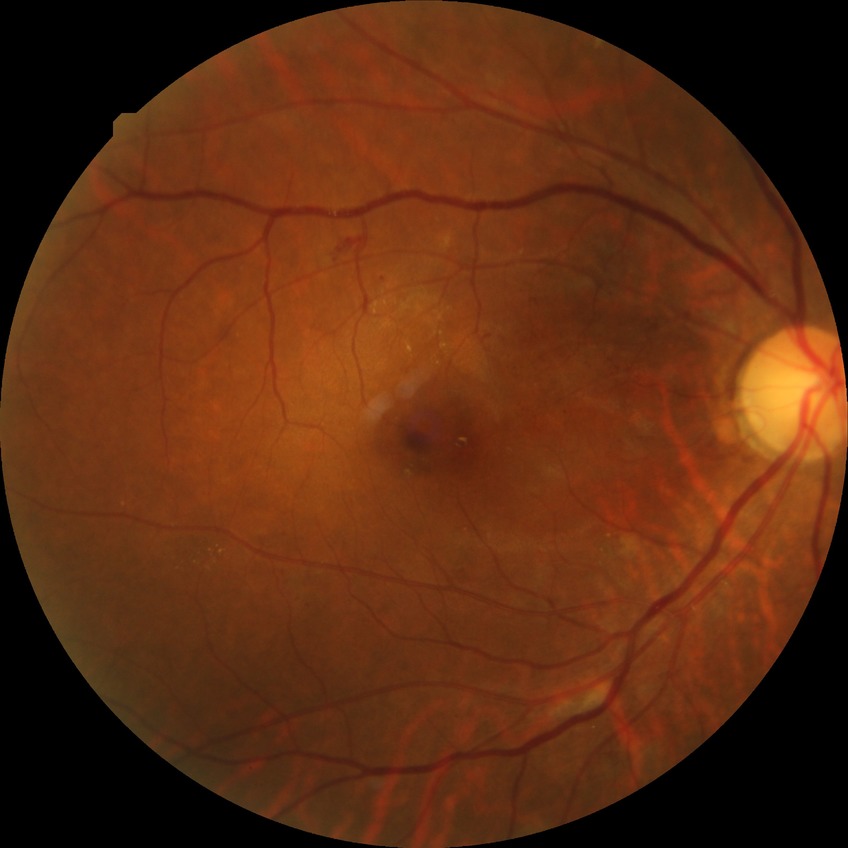 {
  "davis_grade": "PPDR"
}